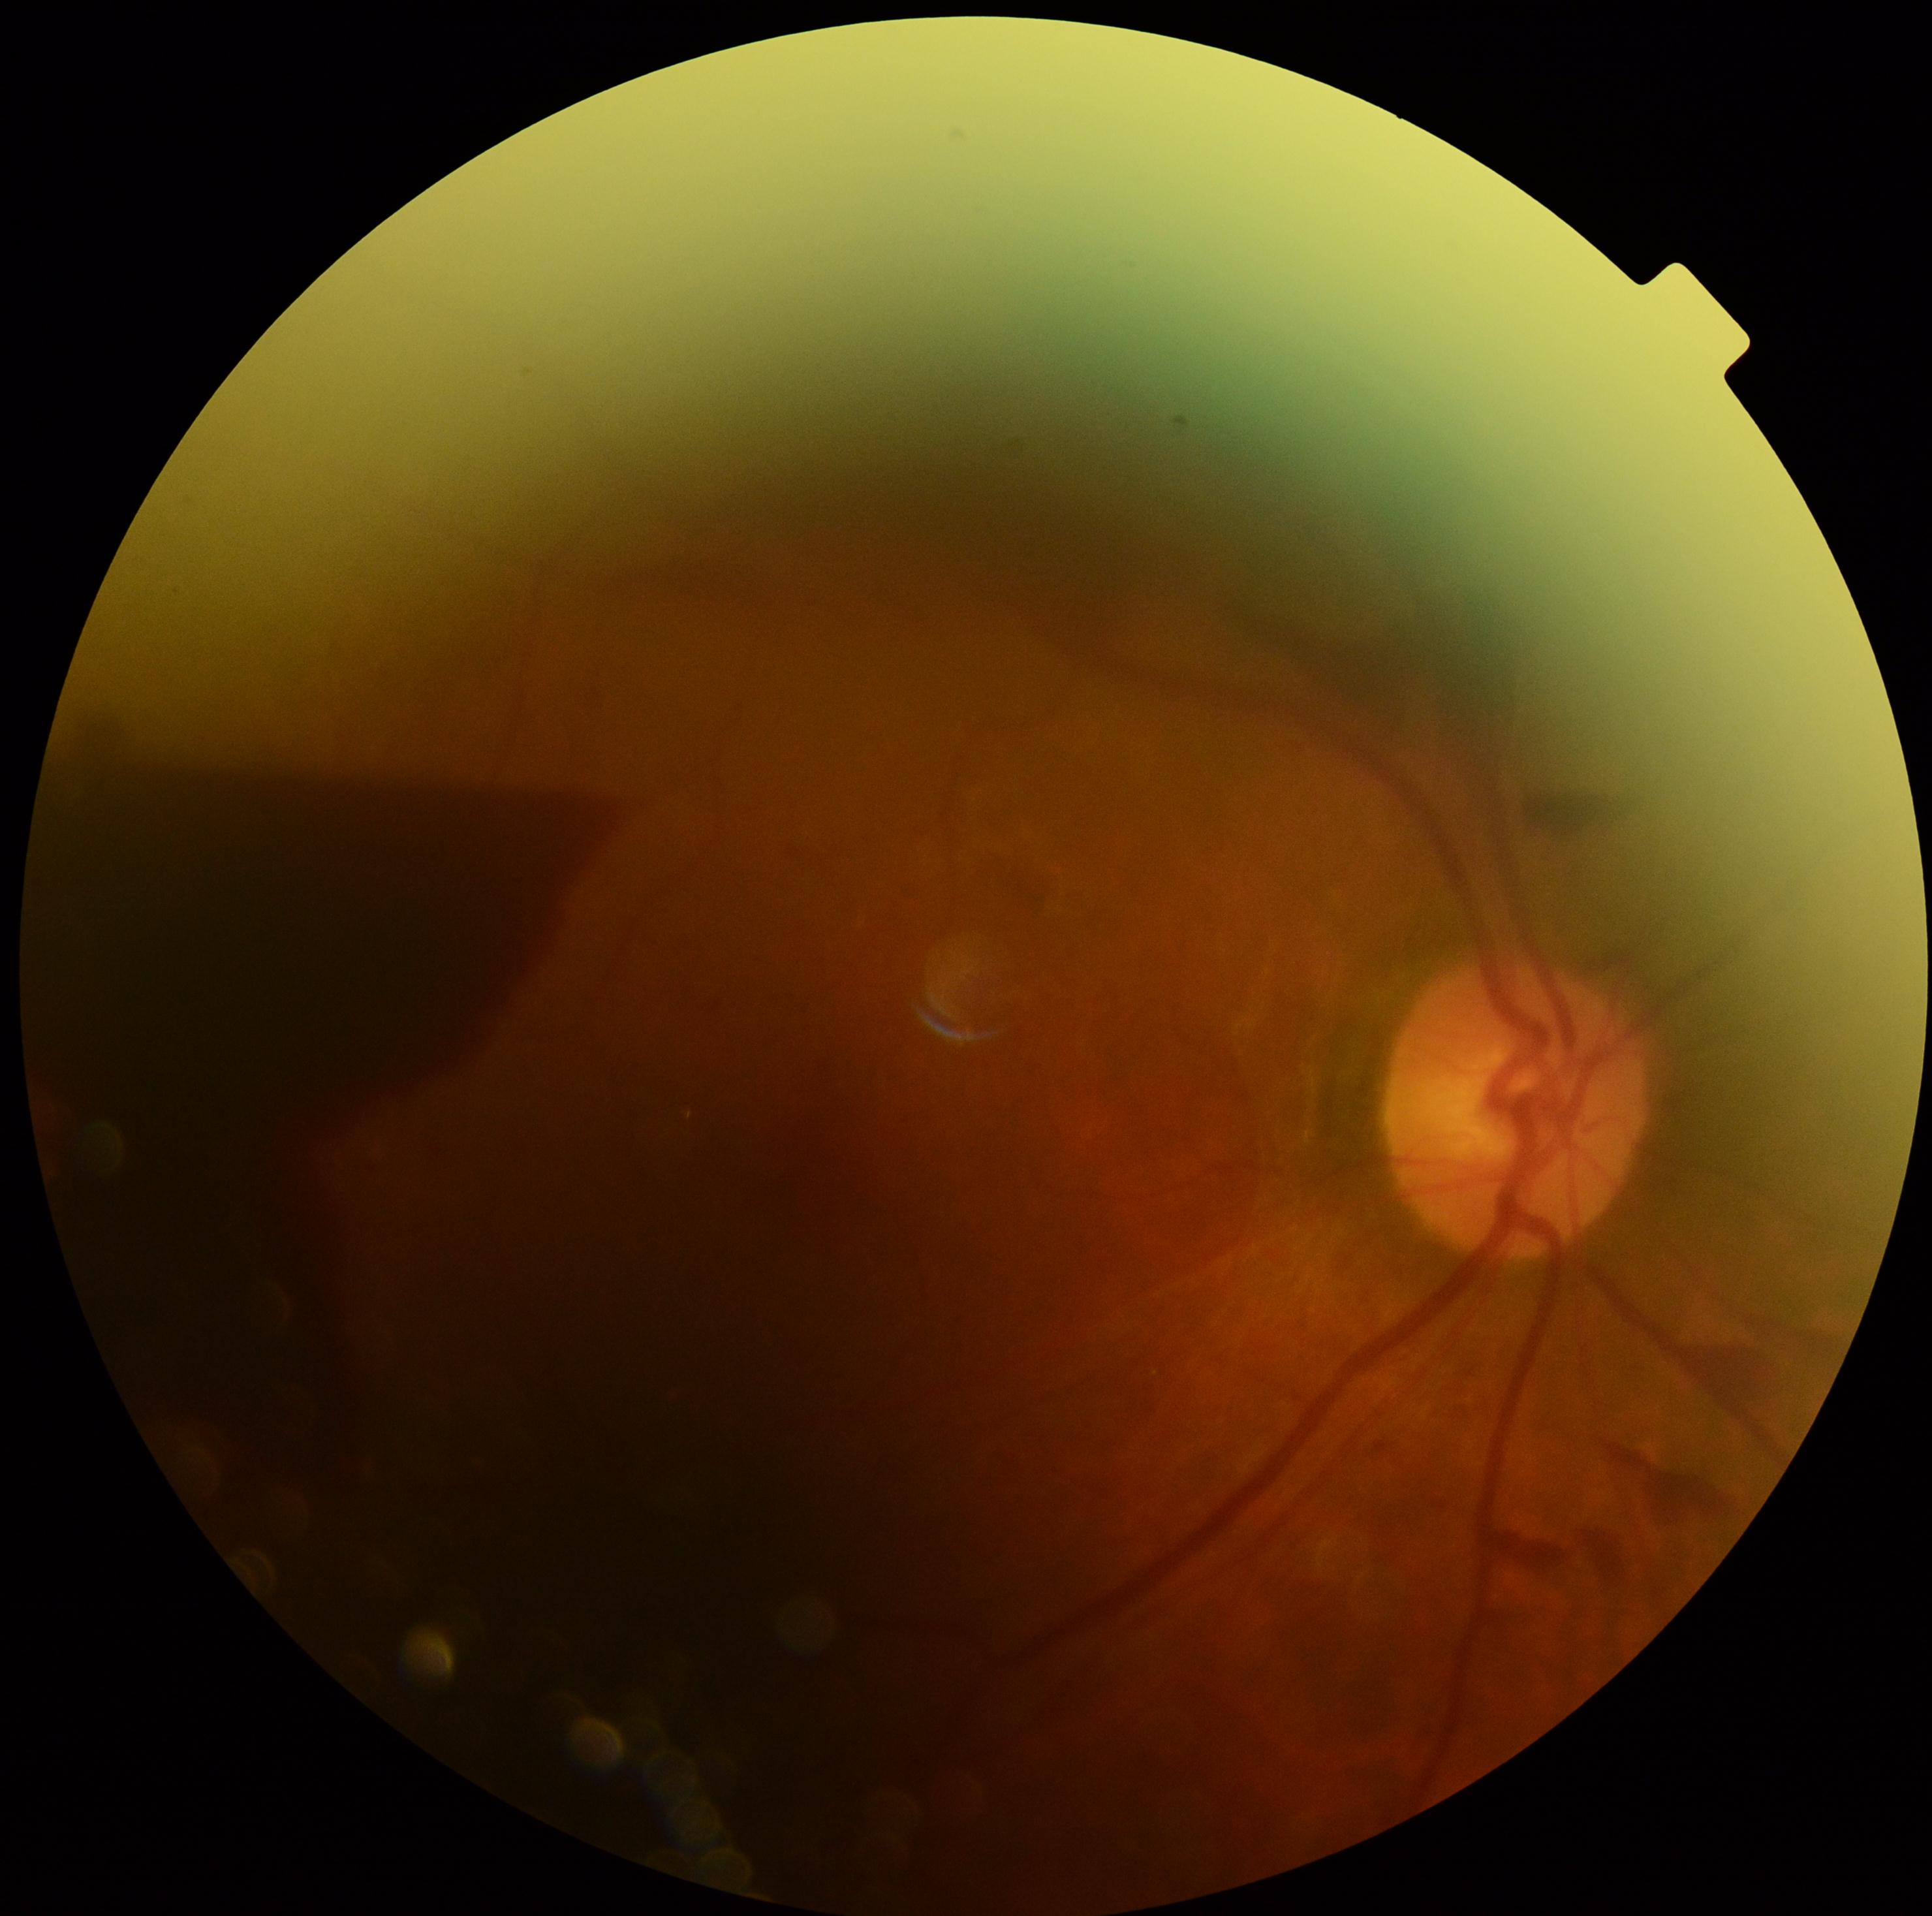 DR grade is 4 (PDR).